Infant wide-field retinal image. Captured with the Natus RetCam Envision (130° field of view) — 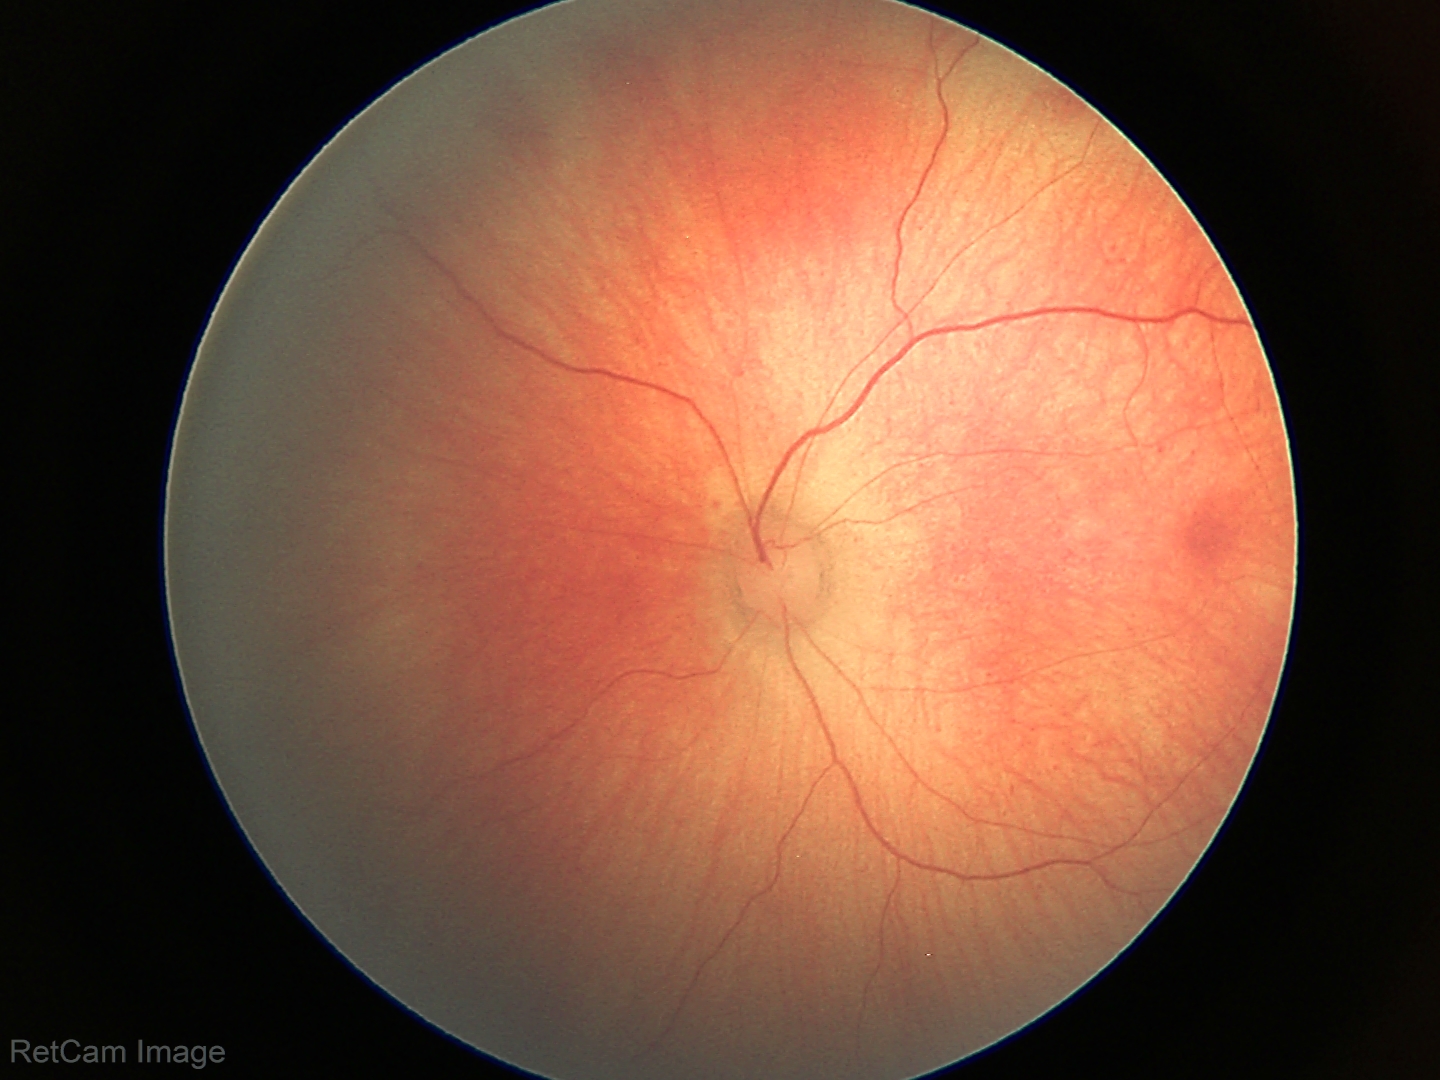 Screening series with retinal hemorrhages.